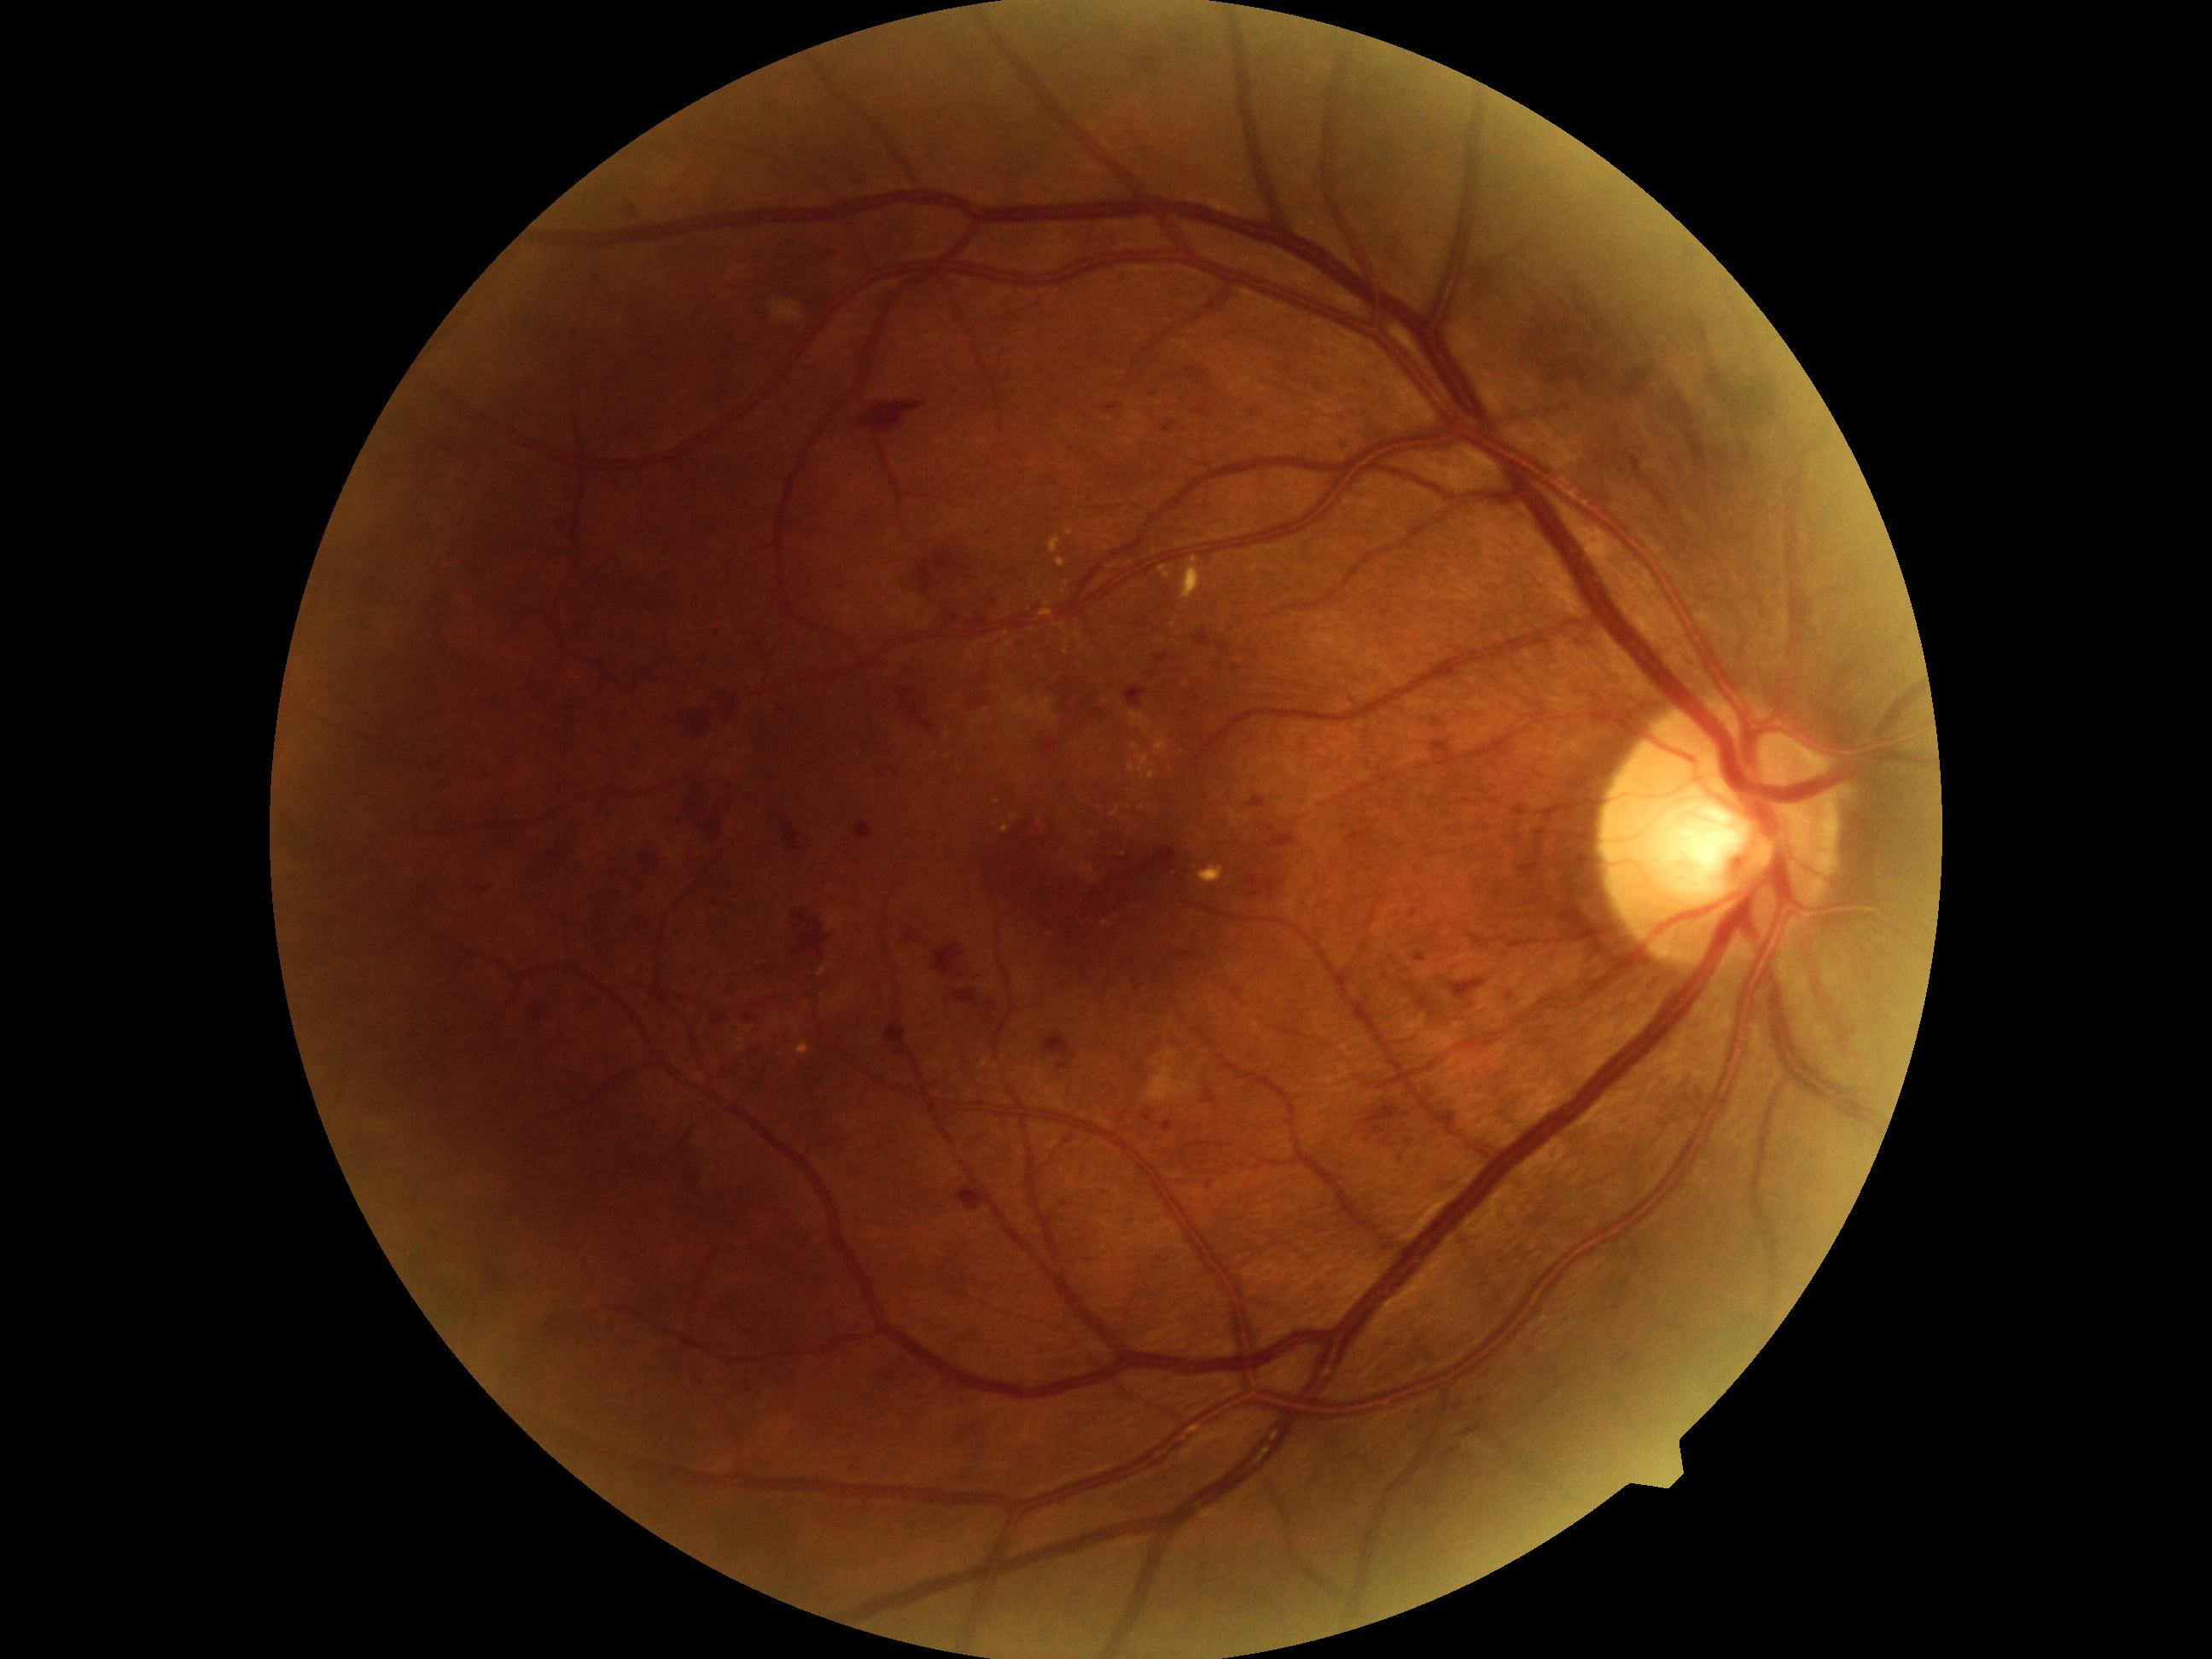
Annotations:
* diabetic retinopathy grade — 2 — more than just microaneurysms but less than severe NPDR